Fundus photo.
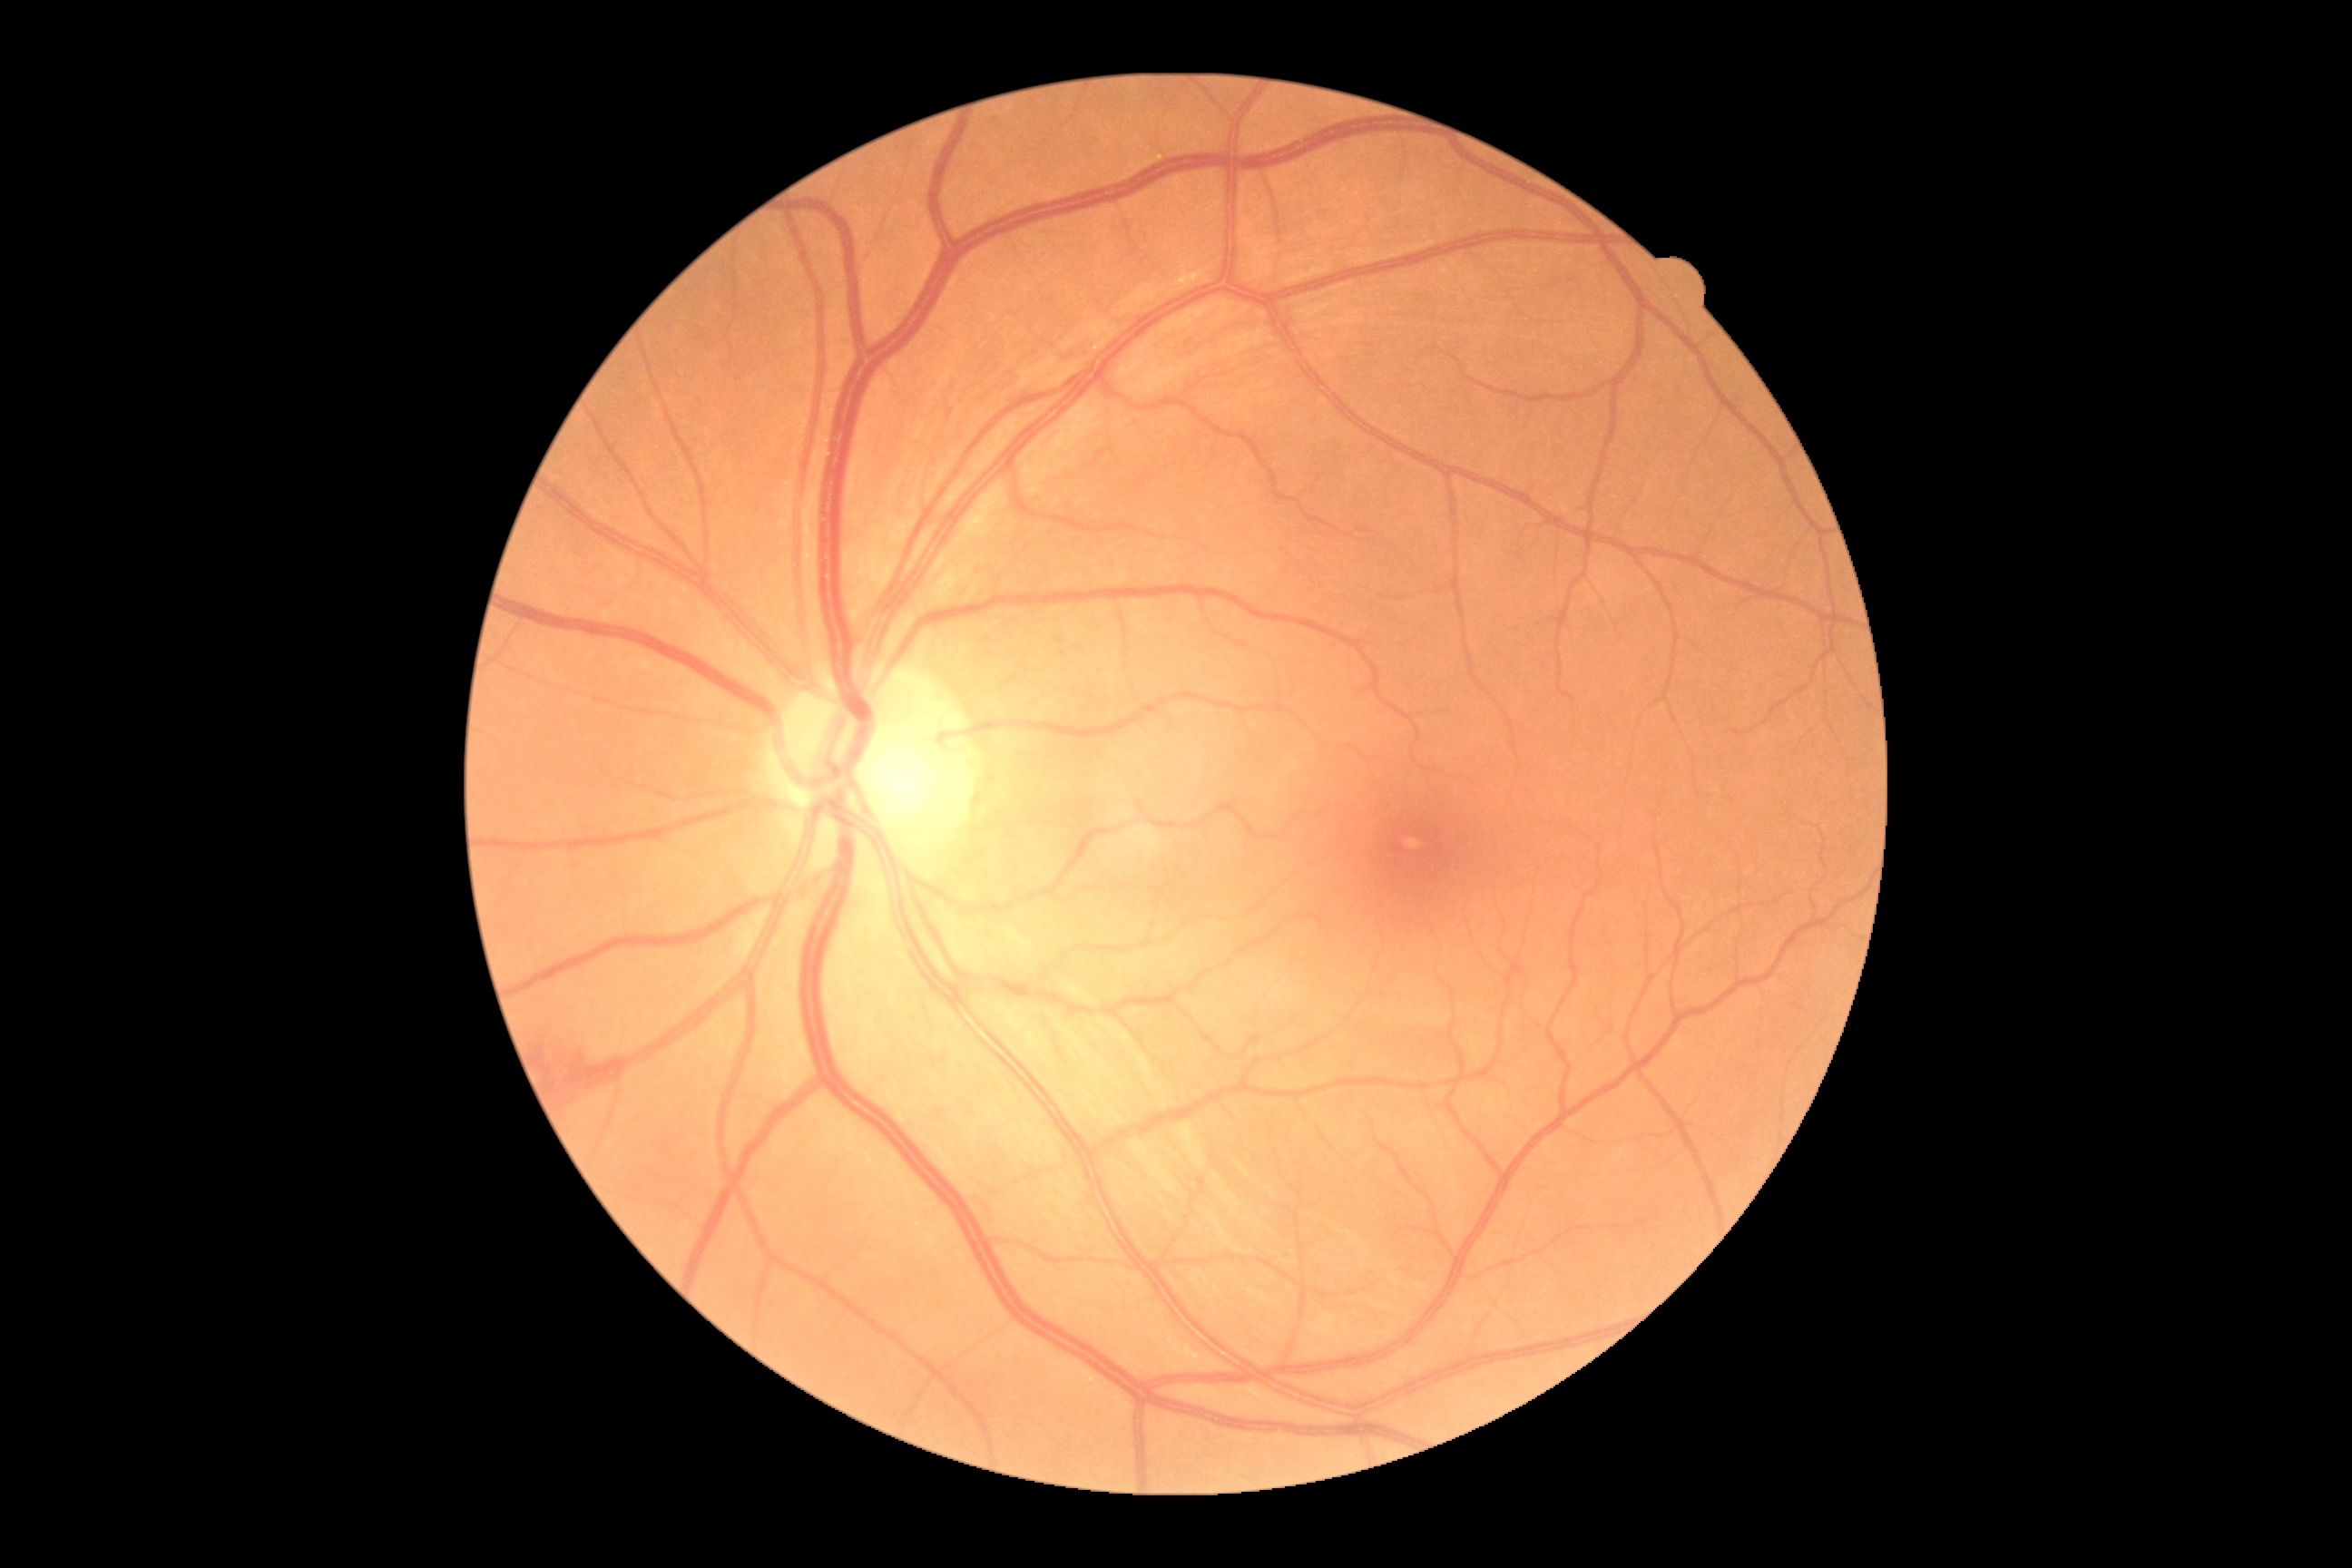 Retinopathy is 2/4.